CFP.
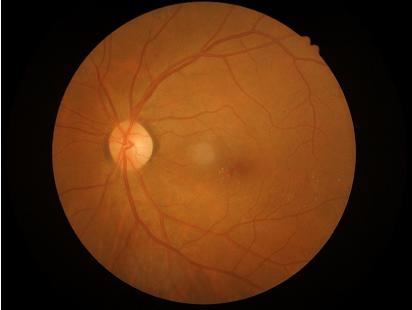
Contrast is good.
No over- or under-exposure.
Acceptable image quality.